45-degree field of view · image size 2352x1568: 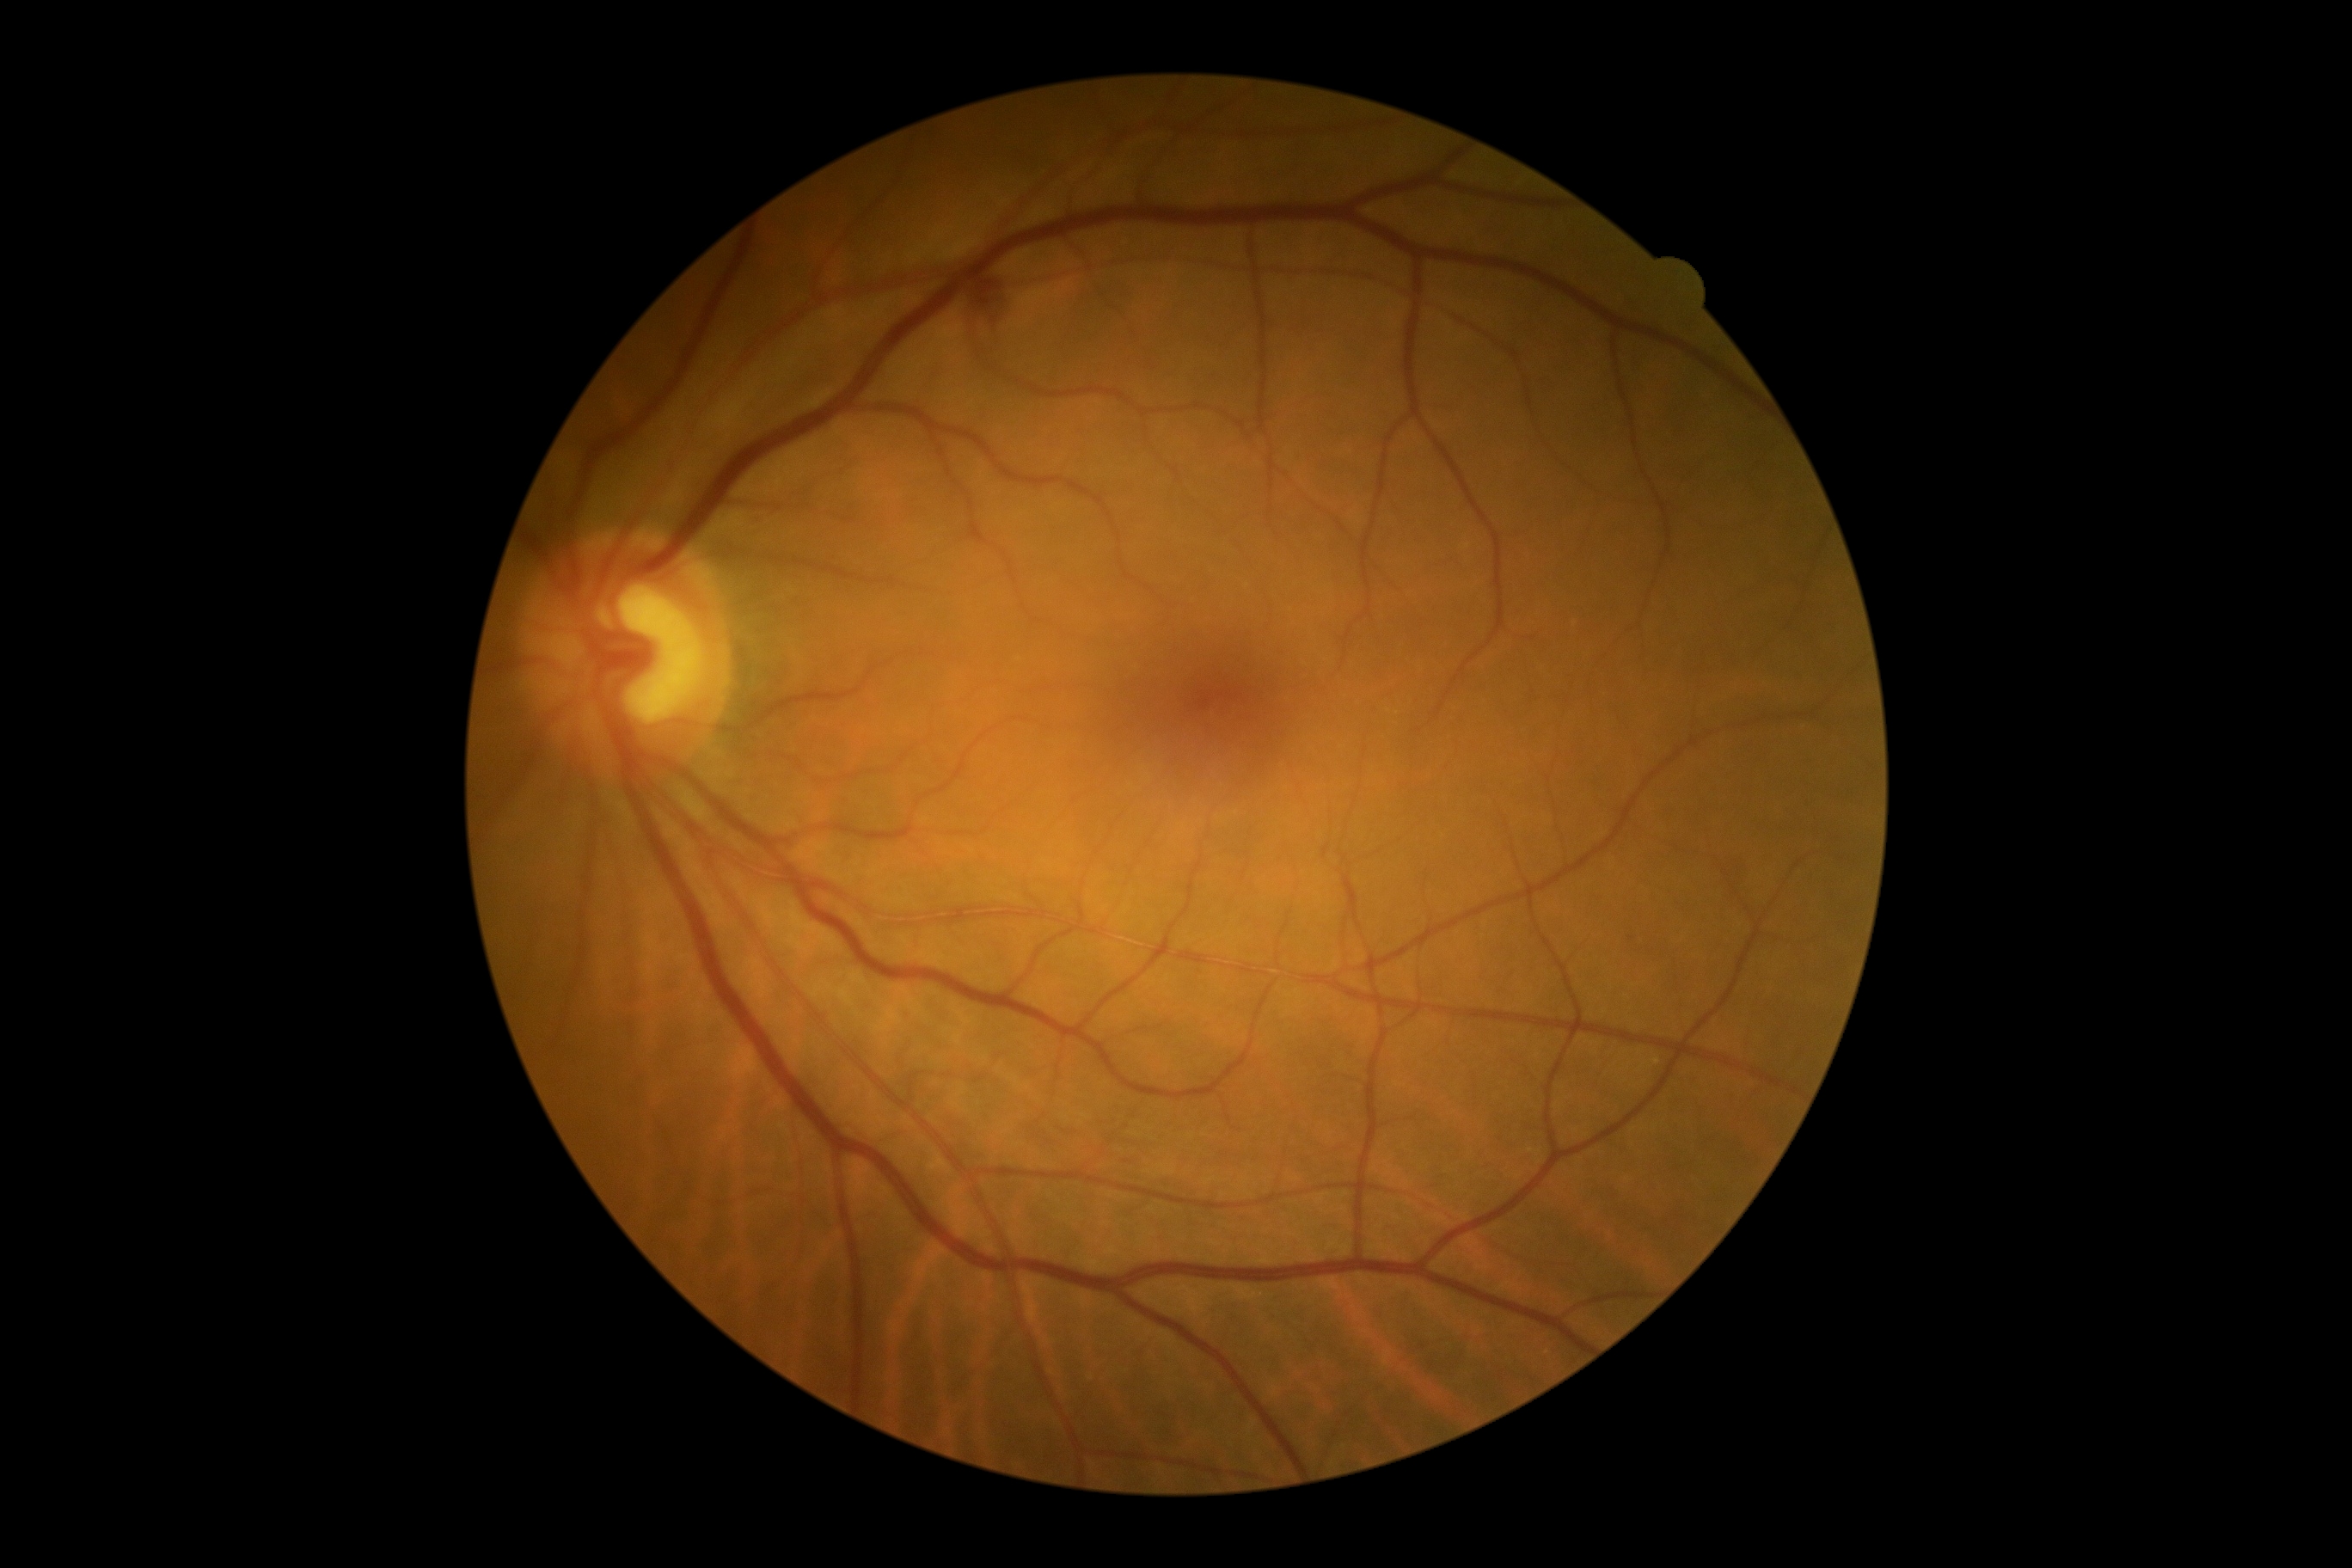
diabetic retinopathy severity=grade 2 (moderate NPDR), DR class=non-proliferative diabetic retinopathy.